DR severity per modified Davis staging, 45° FOV:
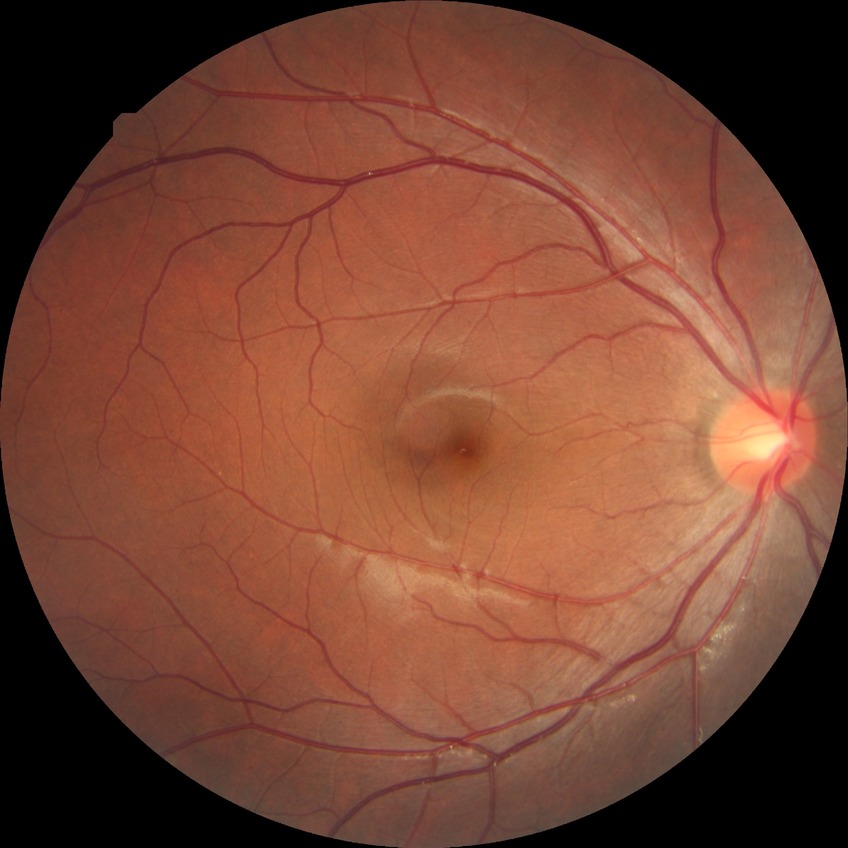 Diabetic retinopathy (DR) is NDR (no diabetic retinopathy).